848x848
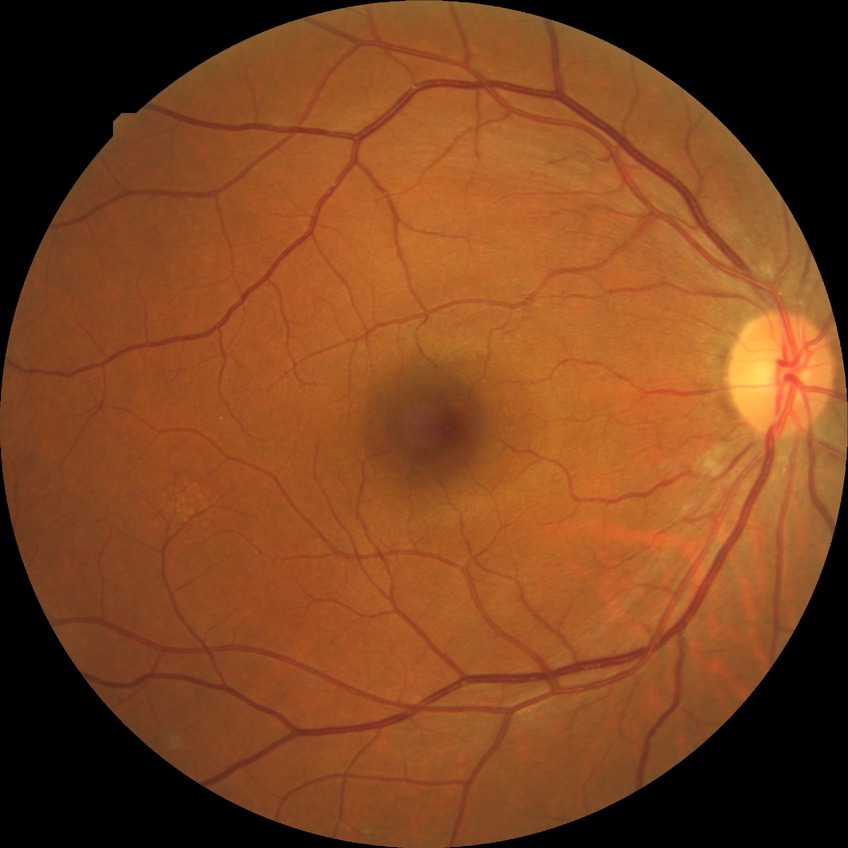

Diabetic retinopathy (DR) is no diabetic retinopathy (NDR).